Fundus photo.
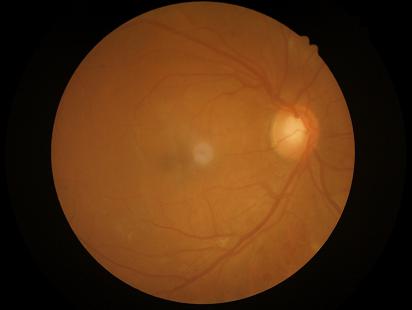

No noticeable blur. Good dynamic range. No over- or under-exposure. Image quality is adequate for diagnostic use.